1960 x 1897 pixels. Color fundus photograph:
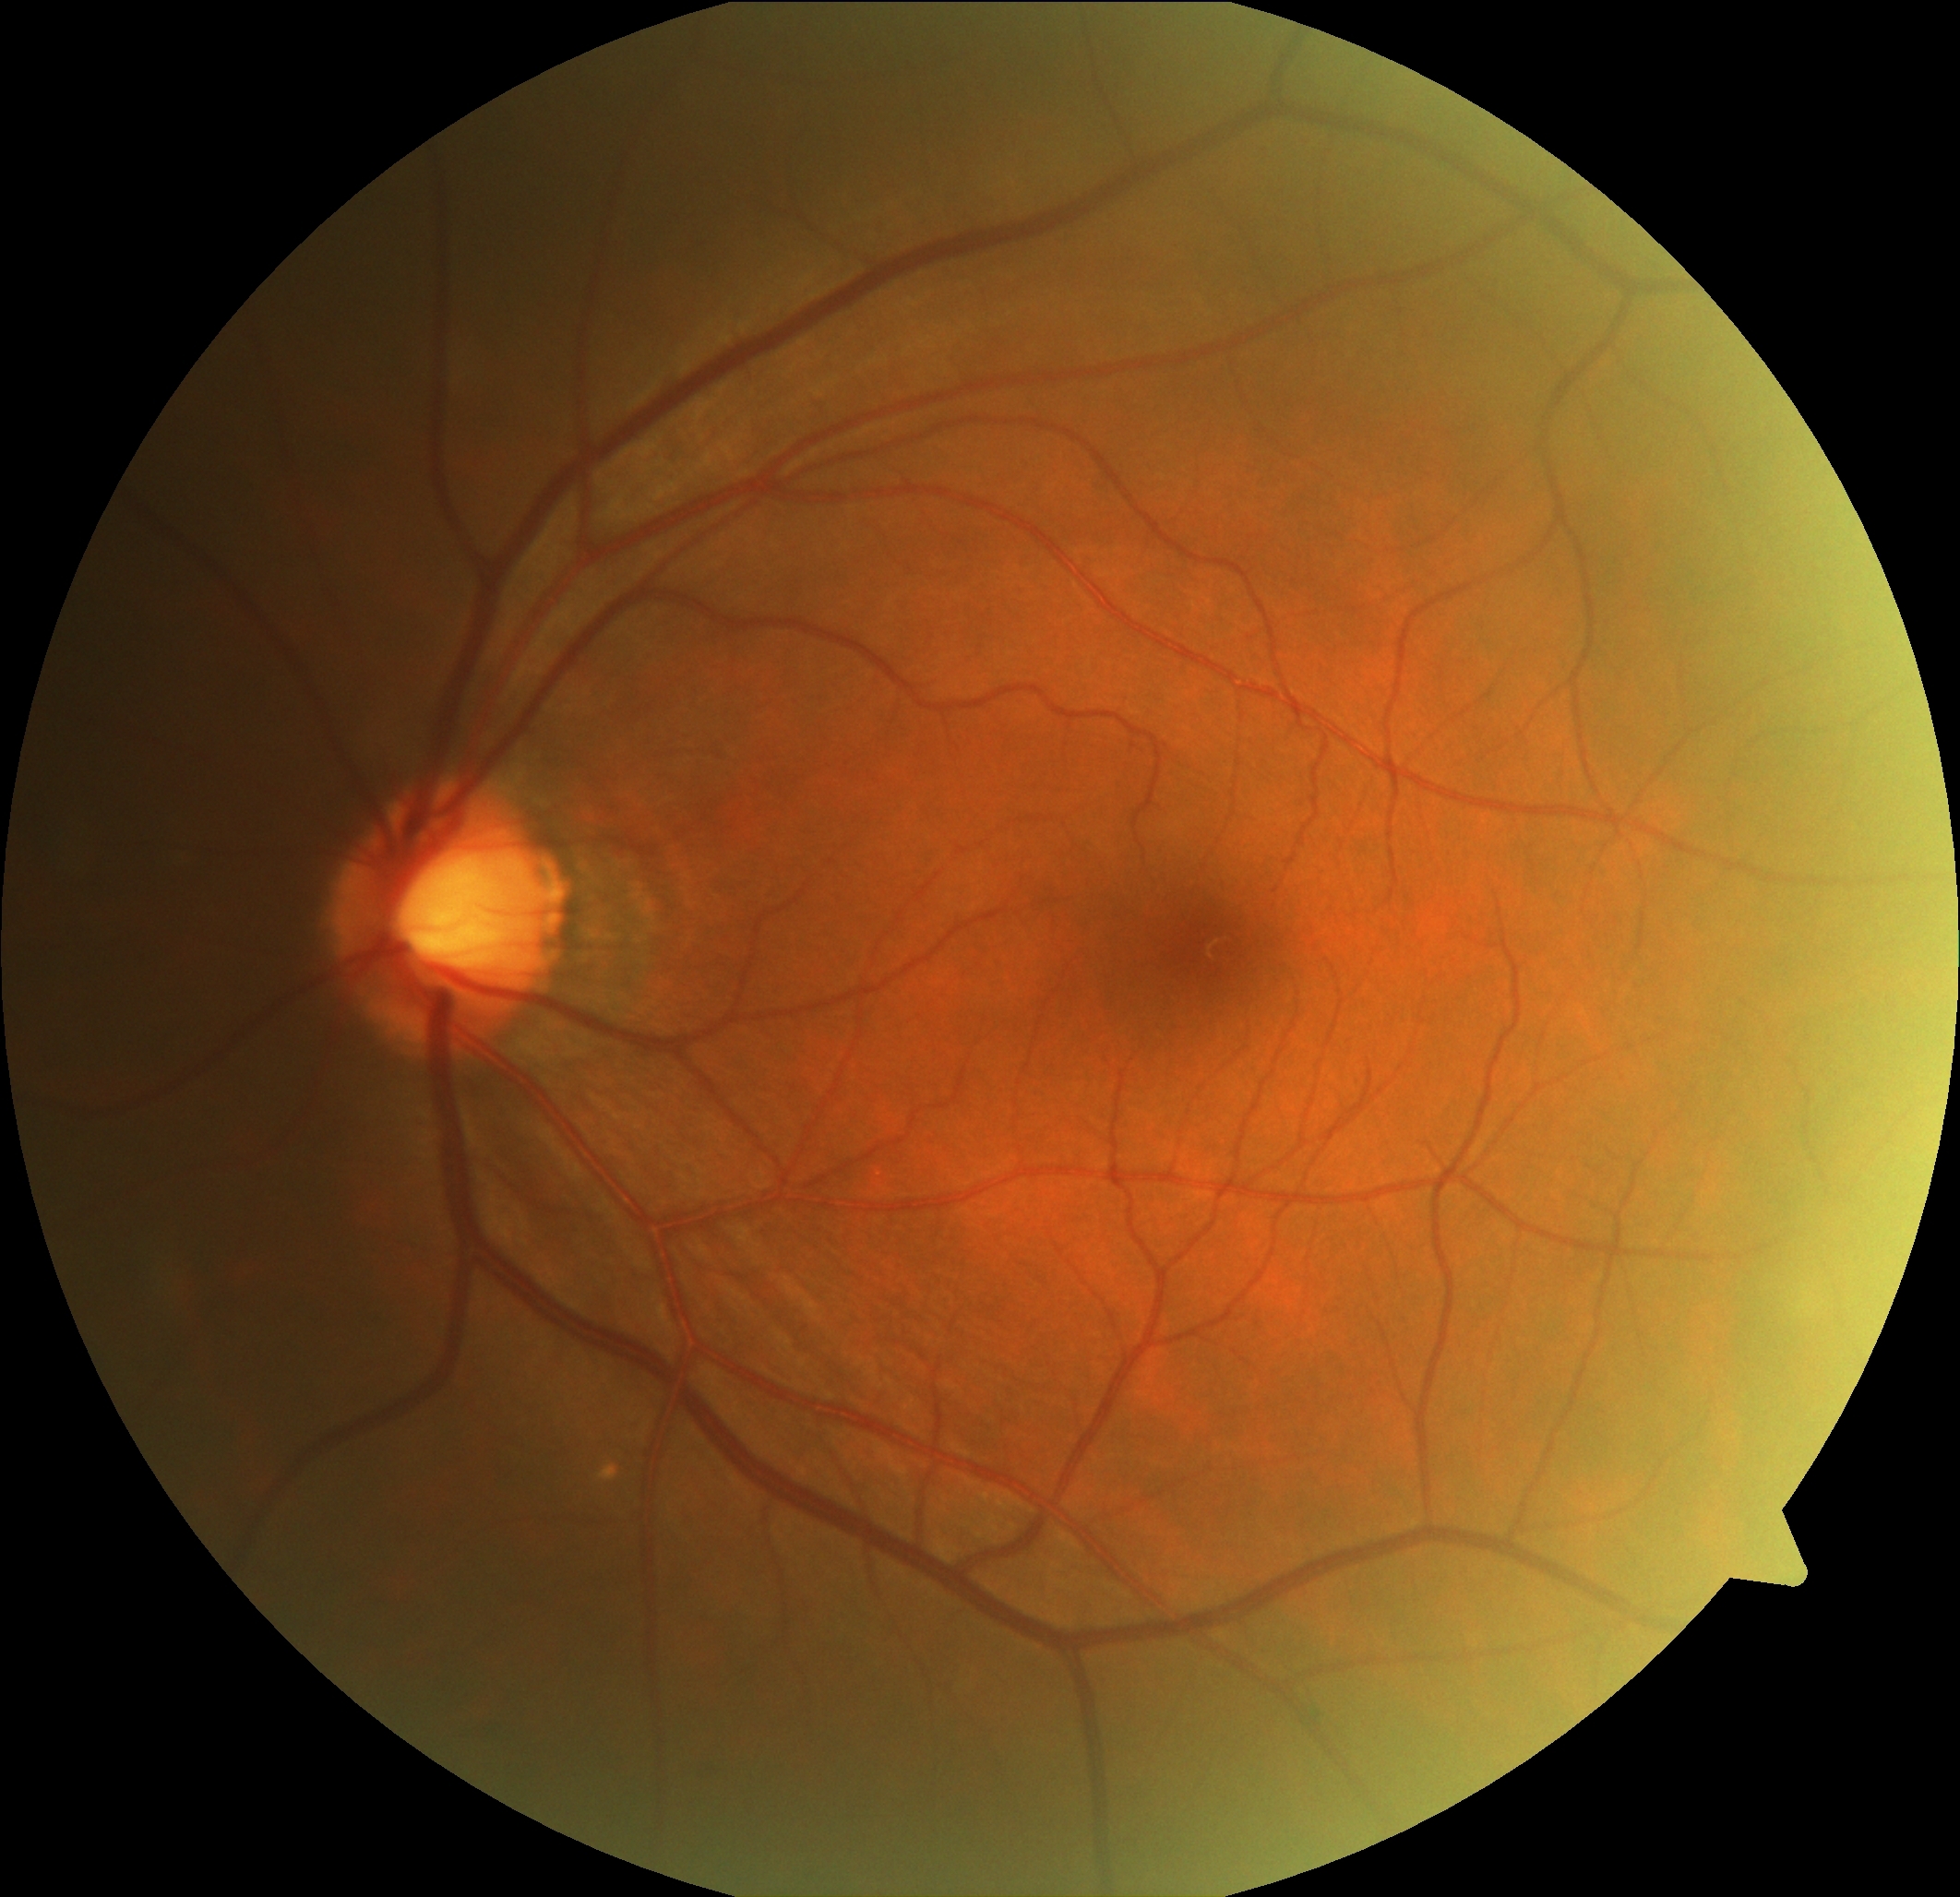

DR impression: no apparent DR, DR: grade 0 (no apparent retinopathy) — no visible signs of diabetic retinopathy.